45° FOV · fundus photo:
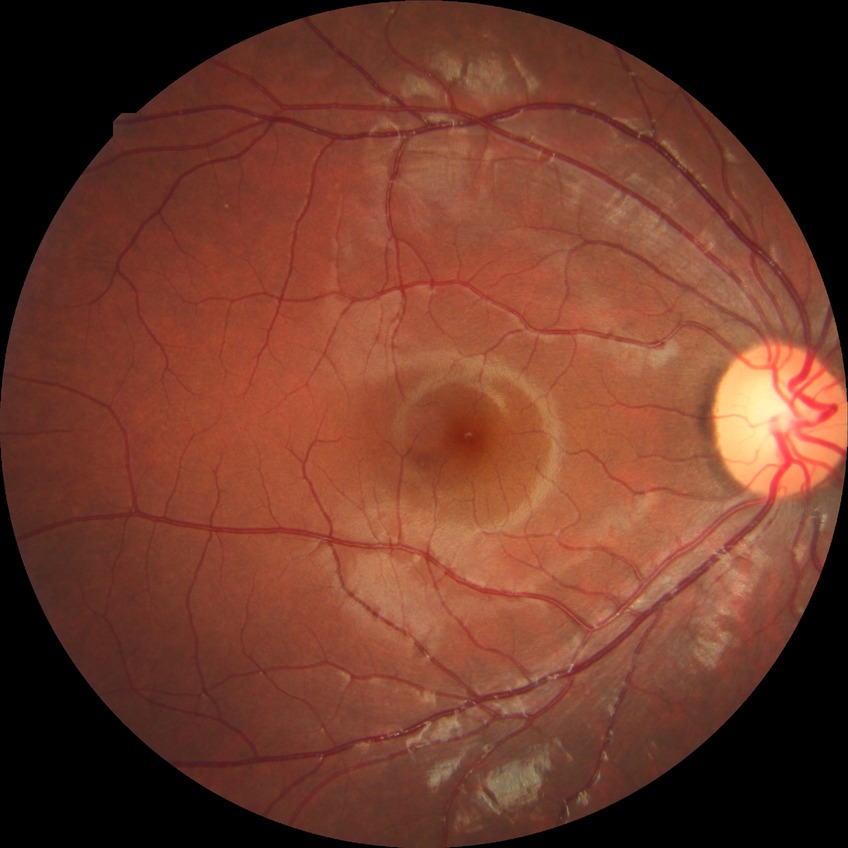 diabetic retinopathy severity: no diabetic retinopathy.